No pharmacologic dilation, 848x848, NIDEK AFC-230, diabetic retinopathy graded by the modified Davis classification: 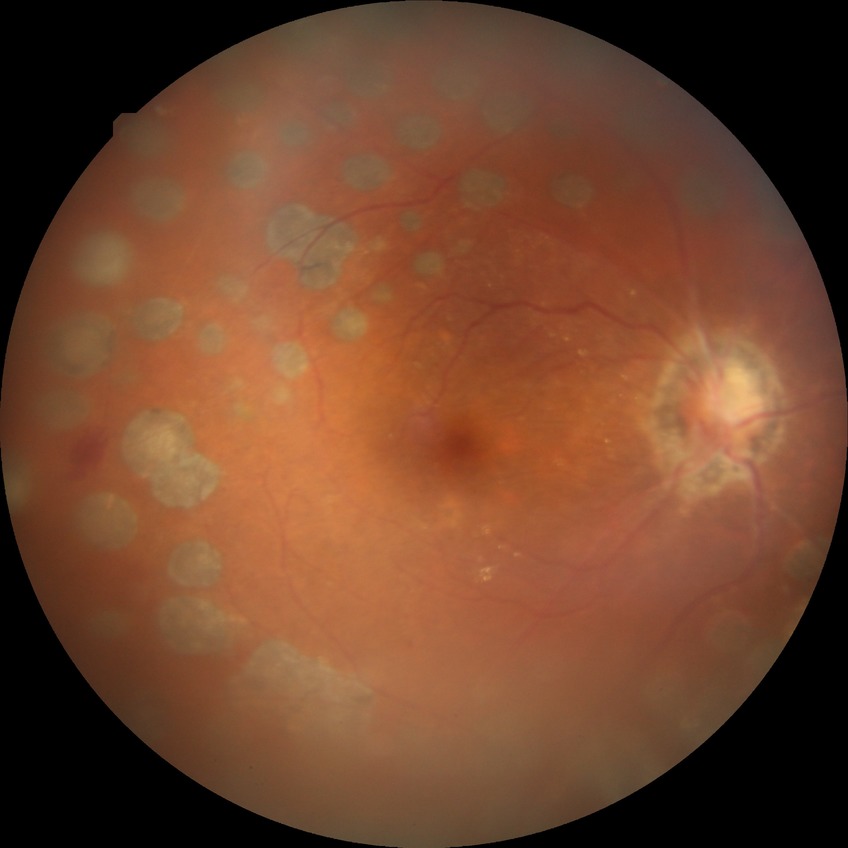

Assessment:
* diabetic retinopathy (DR) — PDR (proliferative diabetic retinopathy)